NIDEK AFC-230.
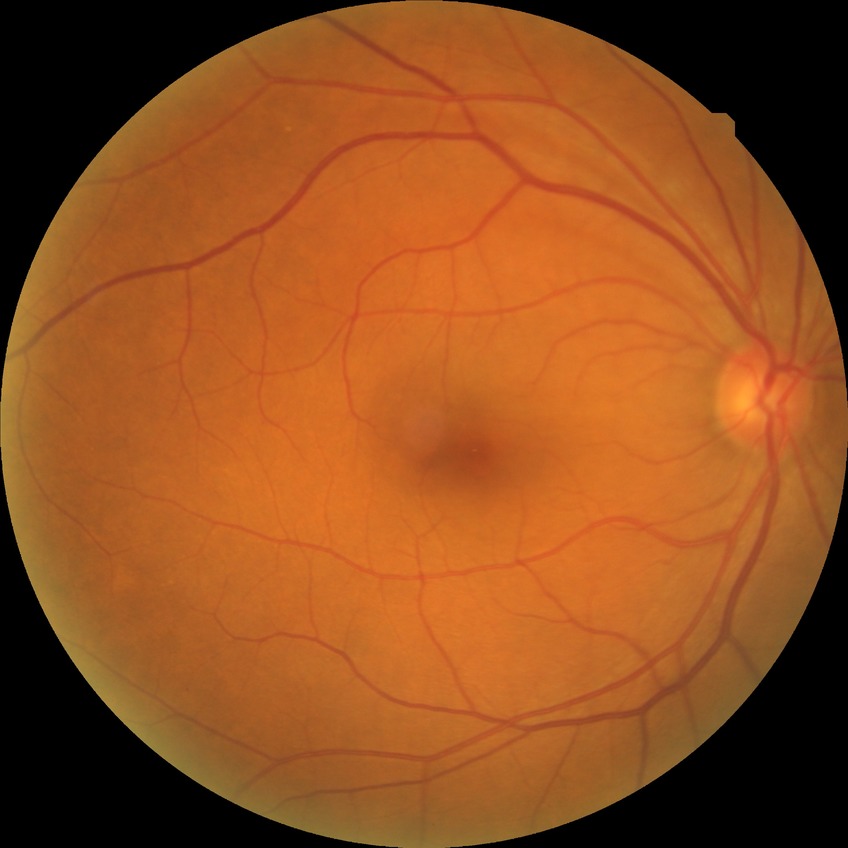 Diabetic retinopathy (DR) is no diabetic retinopathy (NDR).